1932 x 1910 pixels
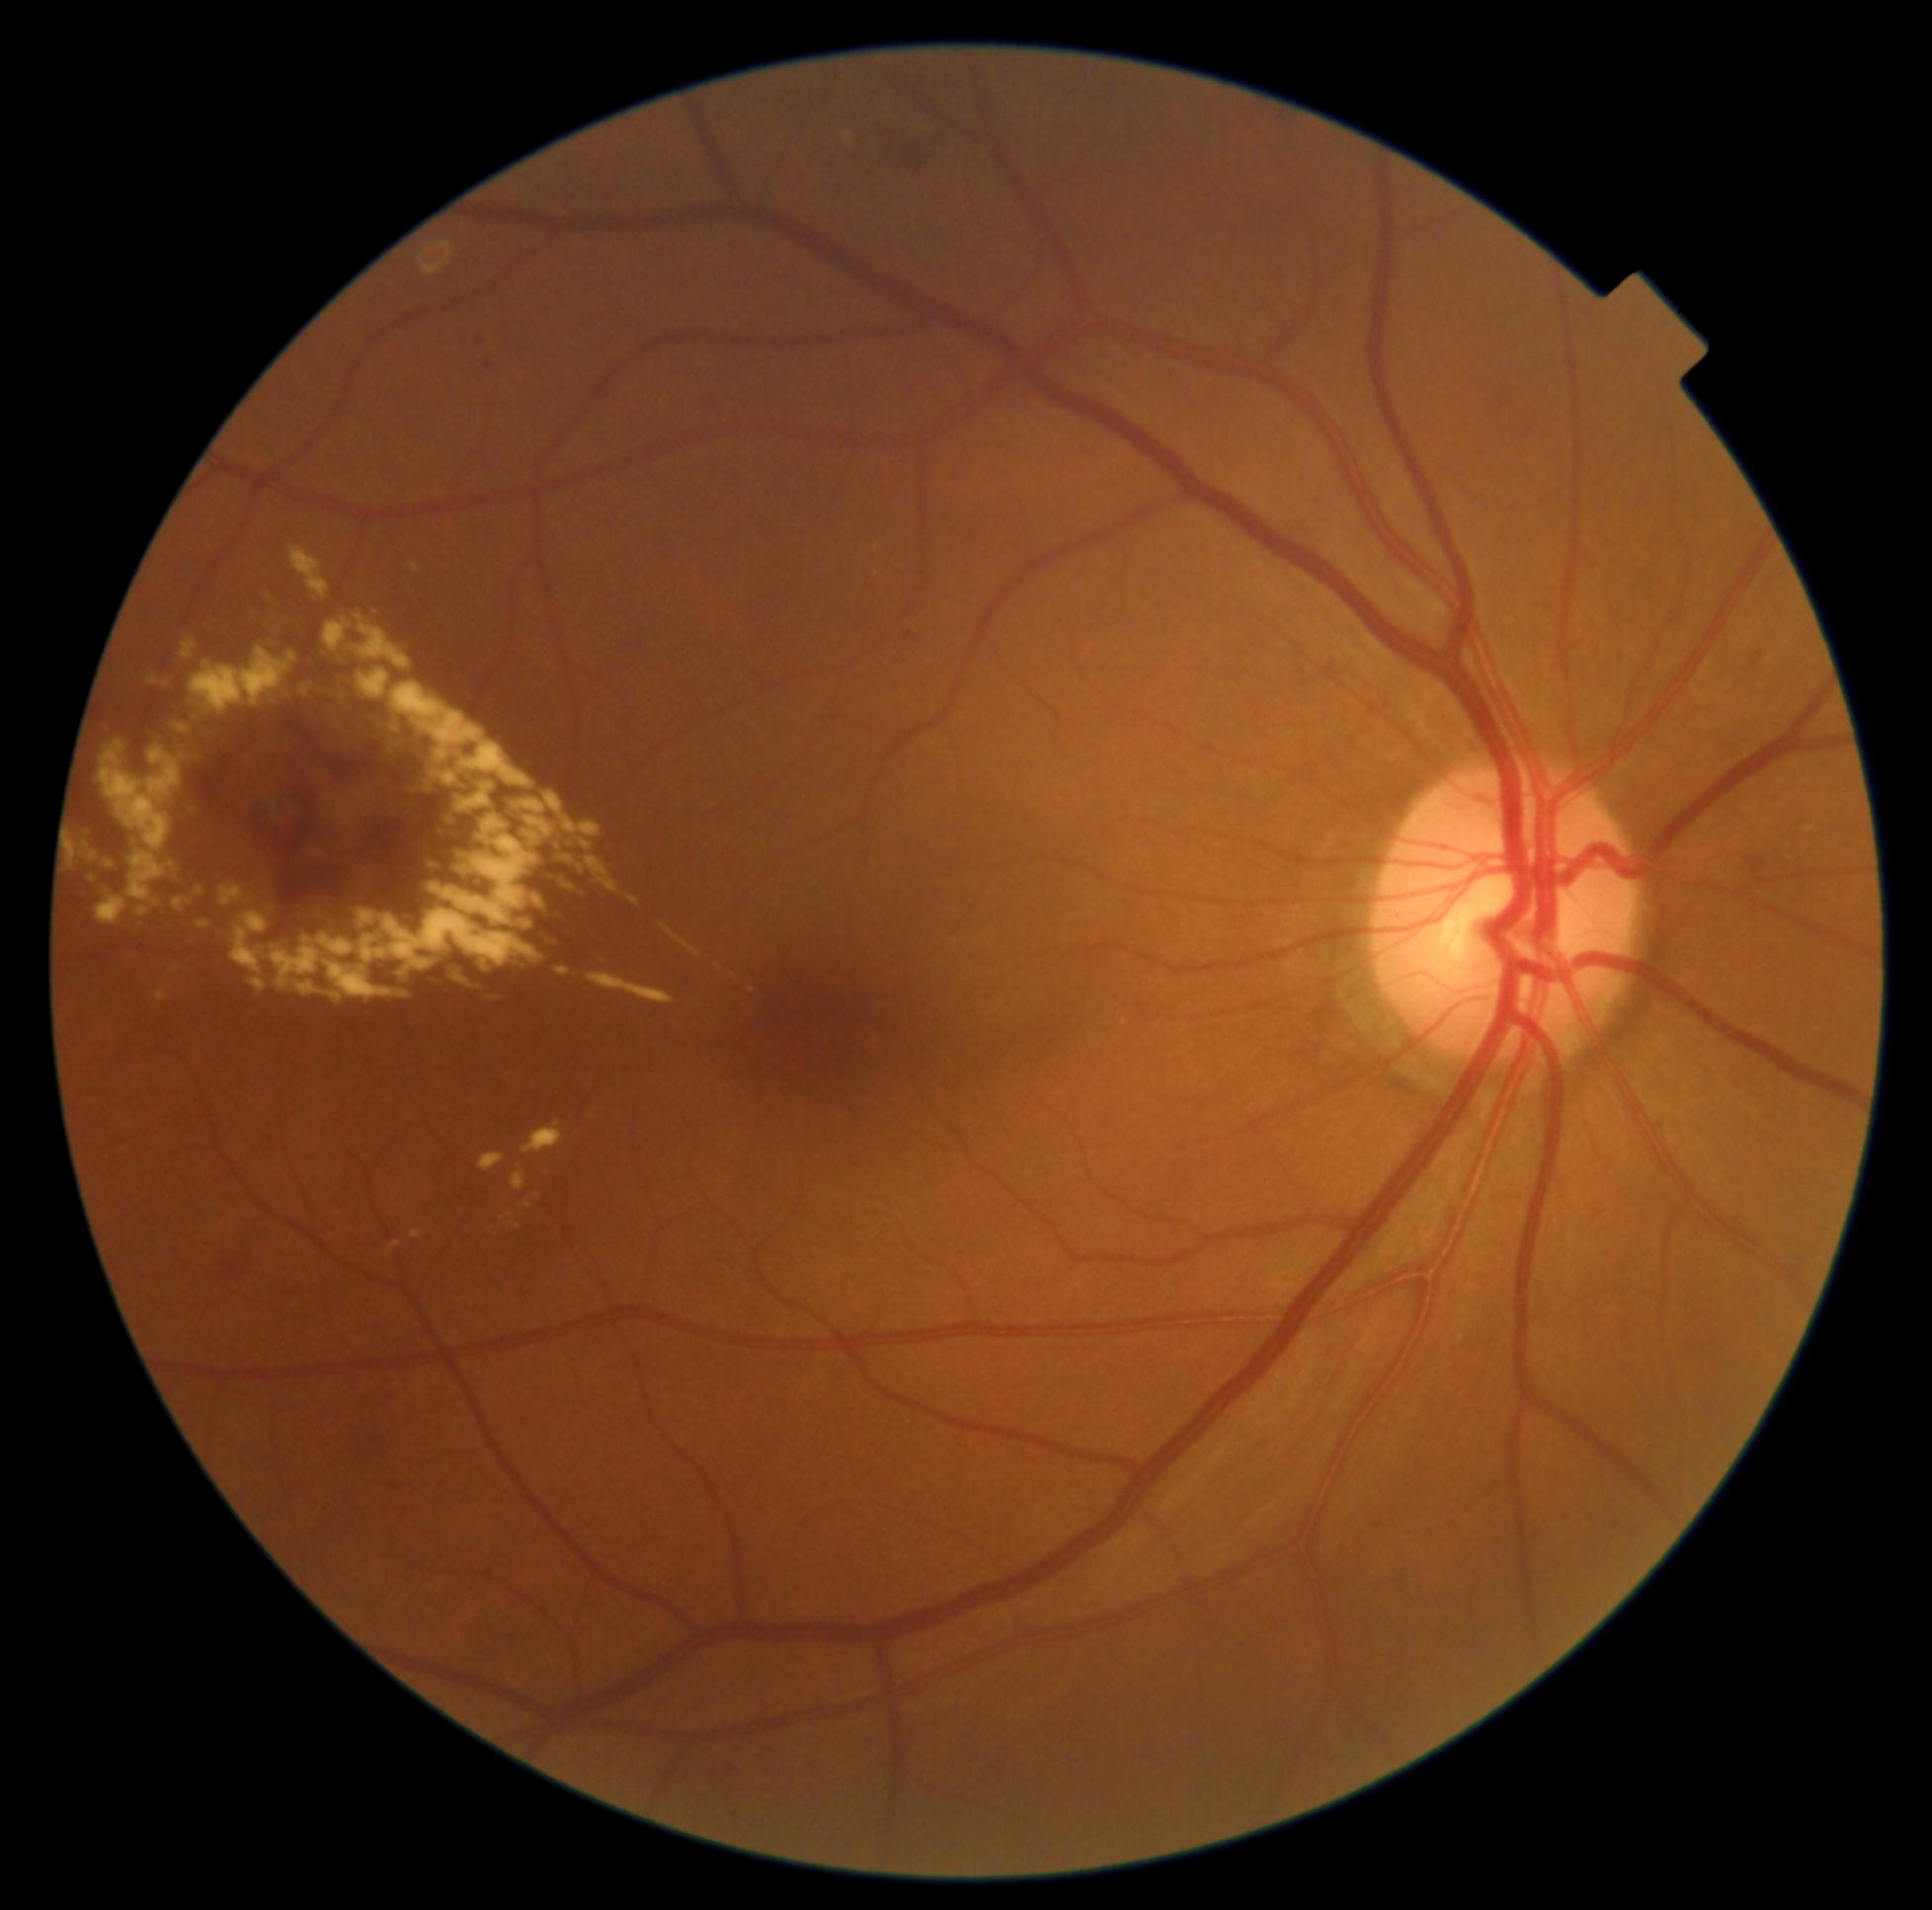 DR severity: grade 2 (moderate NPDR)
Representative lesions:
- EXs (continued): 230:911:269:974; 456:782:496:813; 270:802:281:822; 876:540:881:549; 327:992:344:1002; 190:648:298:714; 197:919:210:929; 199:752:207:764; 462:846:469:861; 267:619:288:633; 324:619:351:652; 295:981:324:996; 84:824:91:833; 474:875:485:890
- Additional small EXs near 569, 859; 172, 866